Diabetic retinopathy graded by the modified Davis classification:
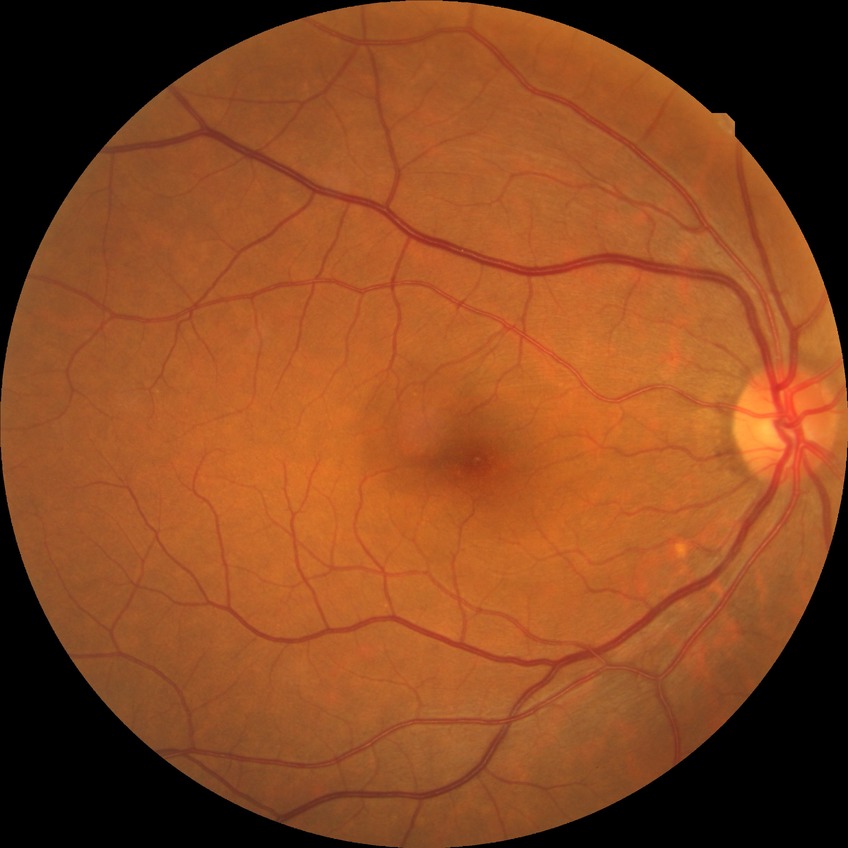 davis_grade: NDR (no diabetic retinopathy)